50° field of view; CFP:
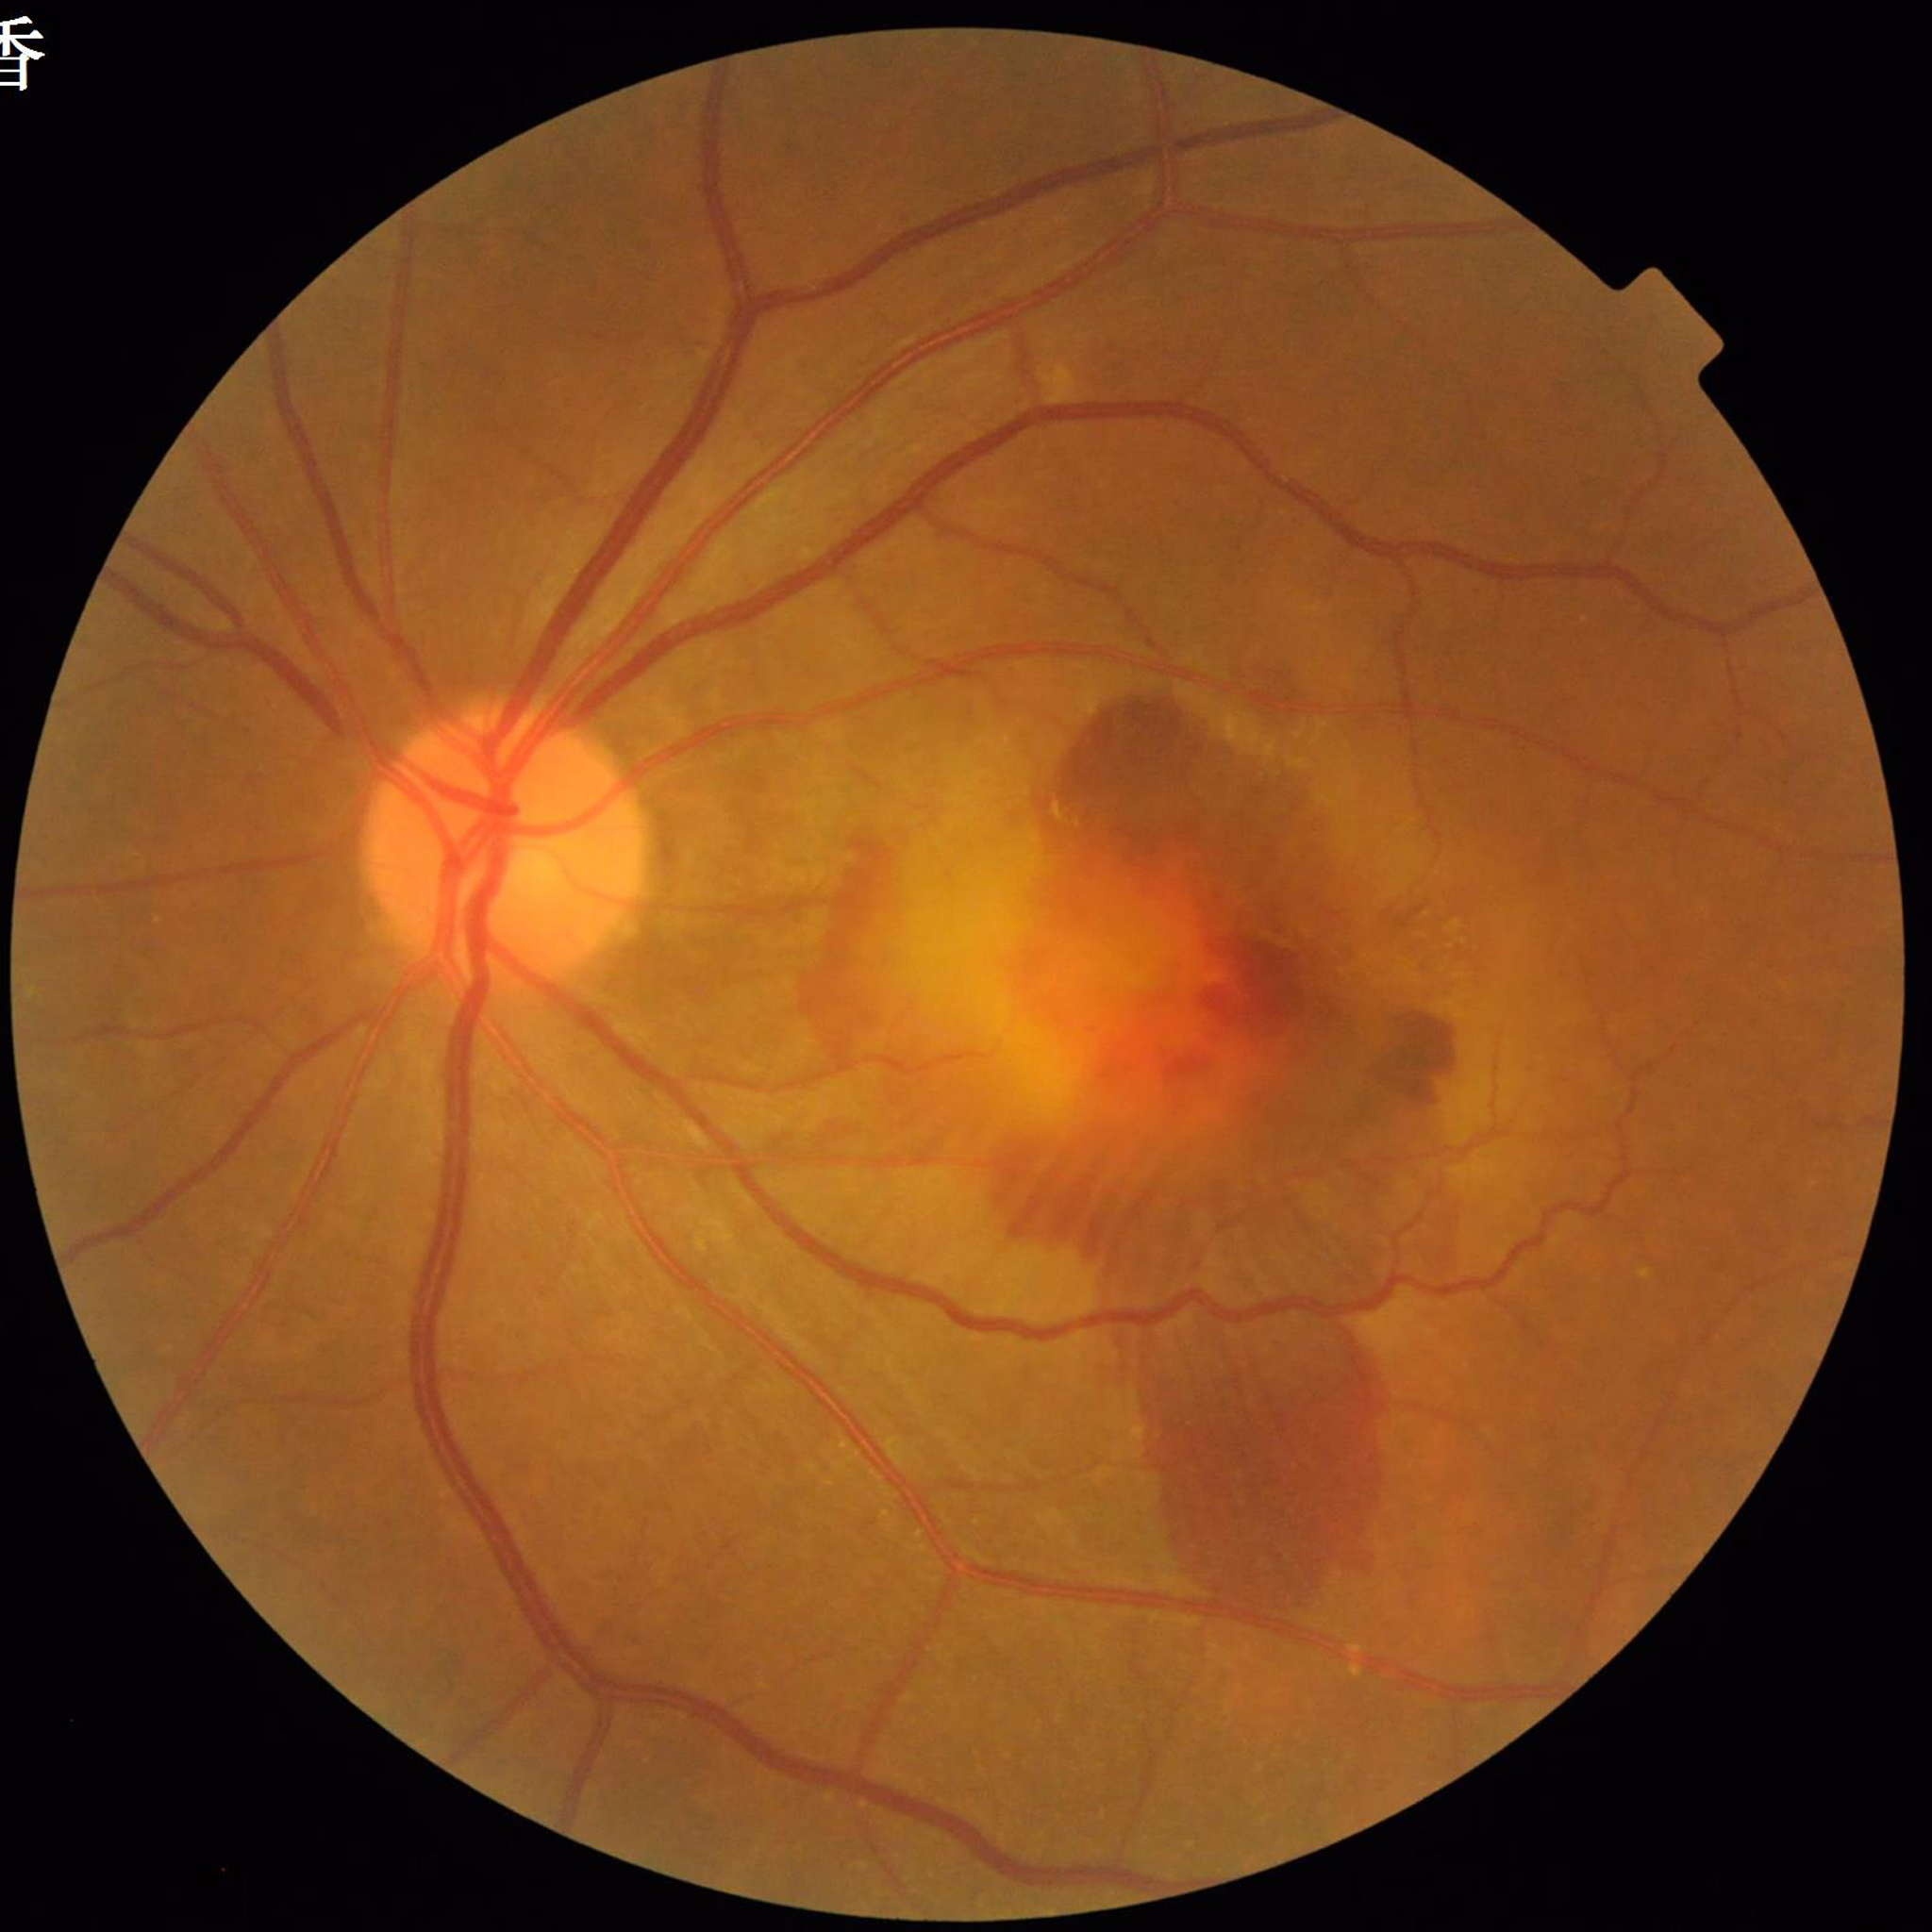 From a patient with age-related macular degeneration.
Automated quality assessment: contrast adequate, illumination and color satisfactory, no blur.